Fundus photo · 768x576: 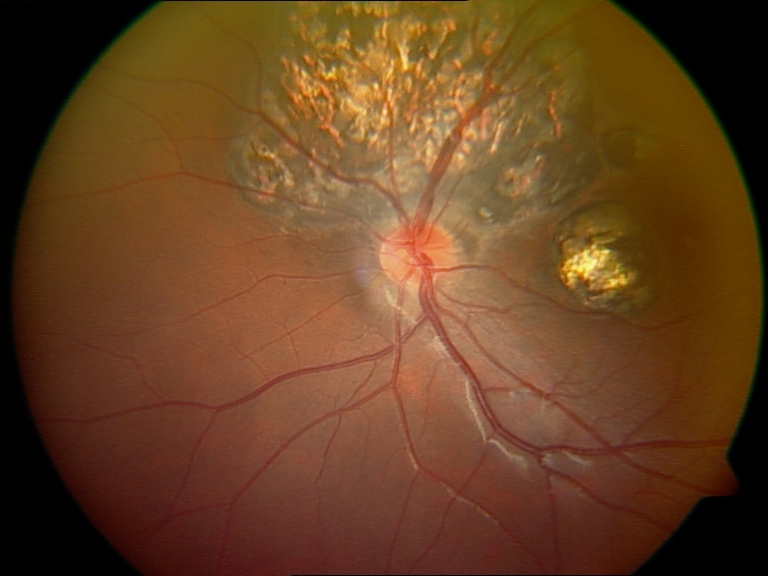

Classification: chorioretinal atrophy or coloboma.